848x848 · no pharmacologic dilation · posterior pole color fundus photograph — 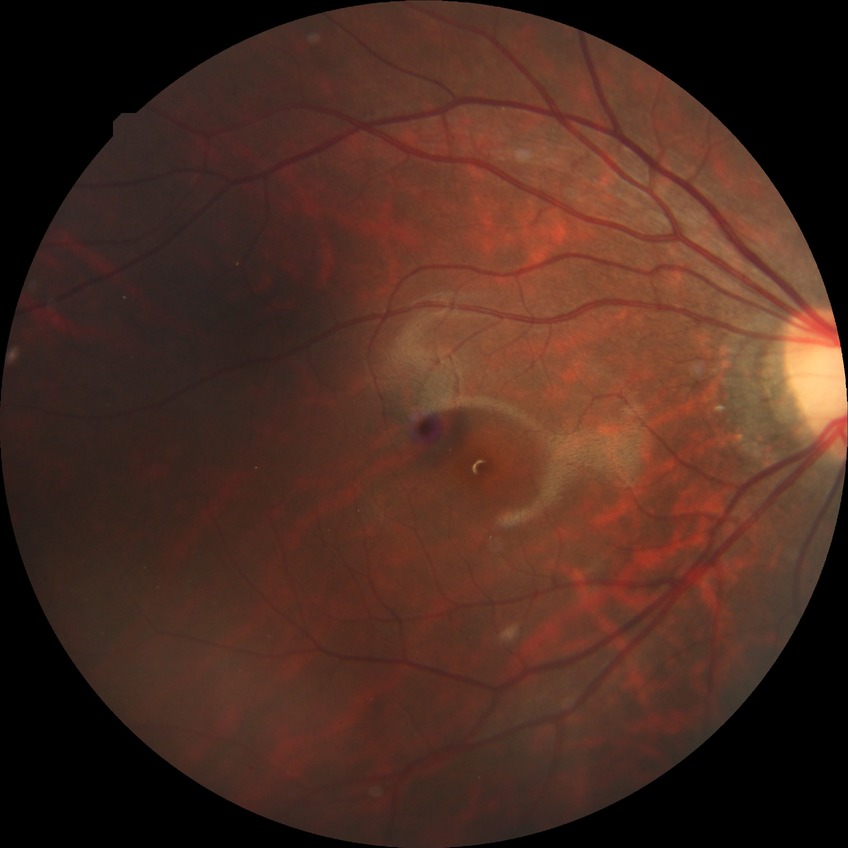 Diabetic retinopathy (DR): no diabetic retinopathy (NDR).